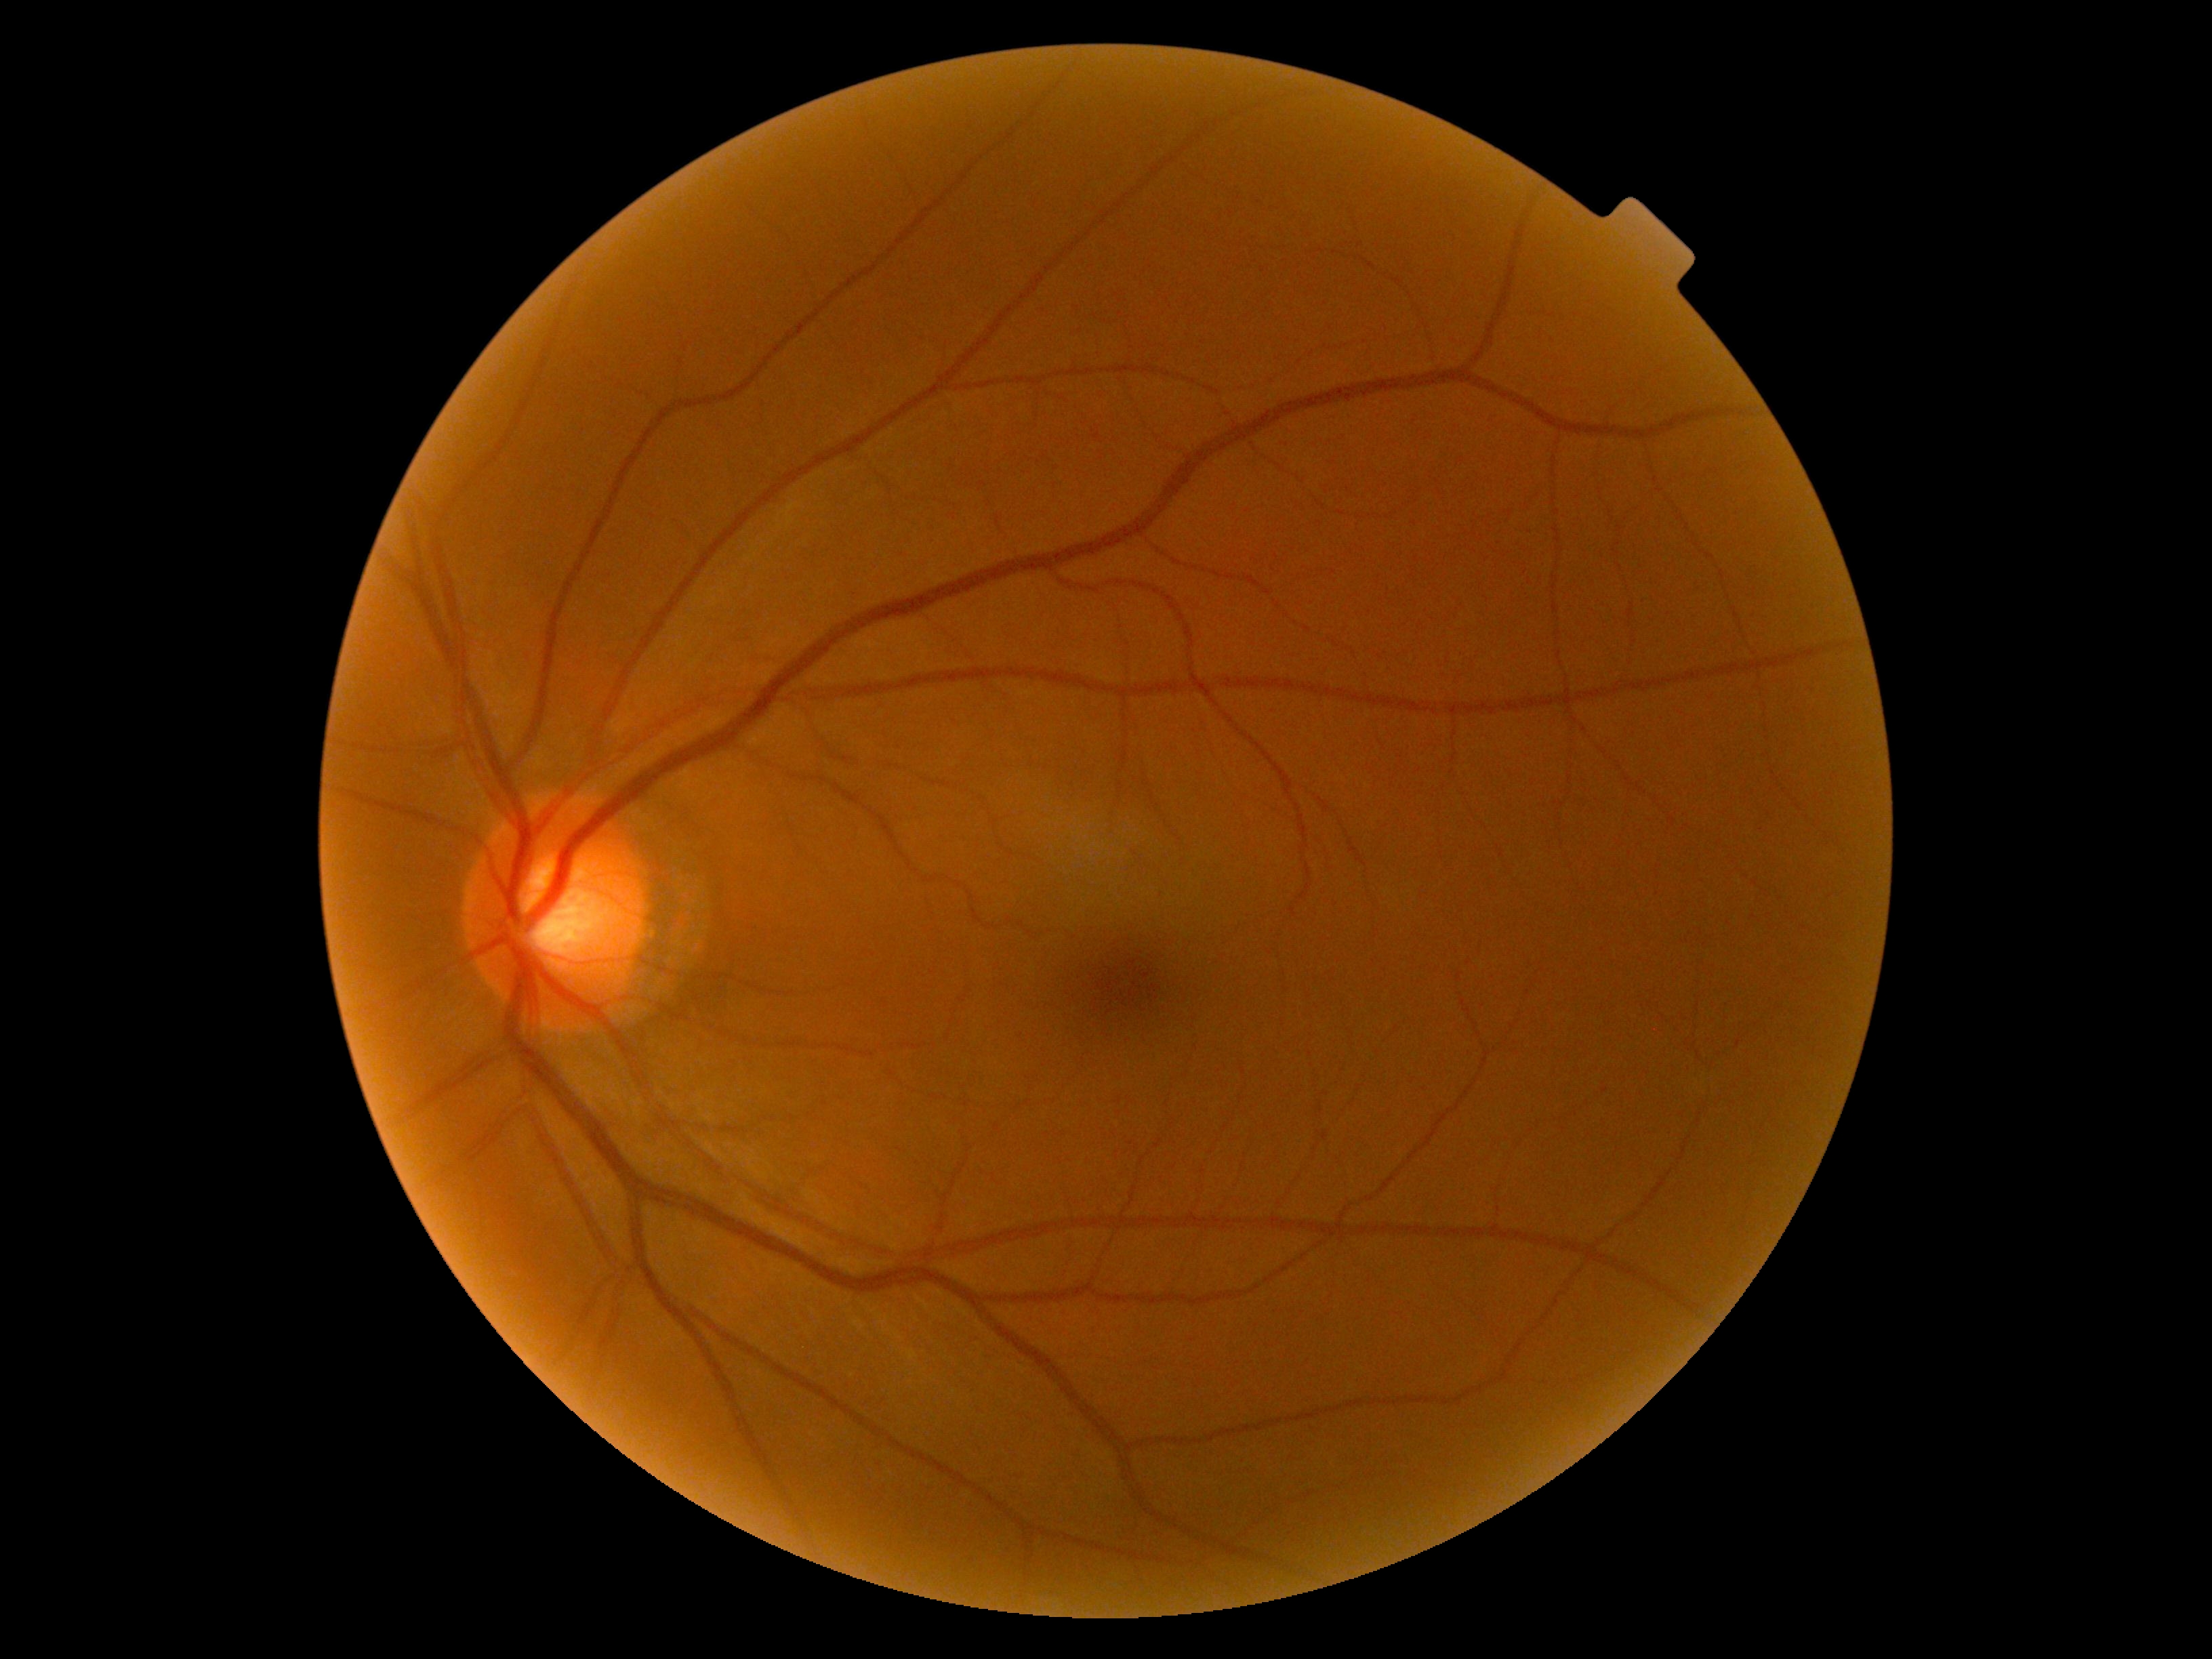
No DR findings.
DR grade is 0.